Captured with the Phoenix ICON (100° field of view) · wide-field contact fundus photograph of an infant — 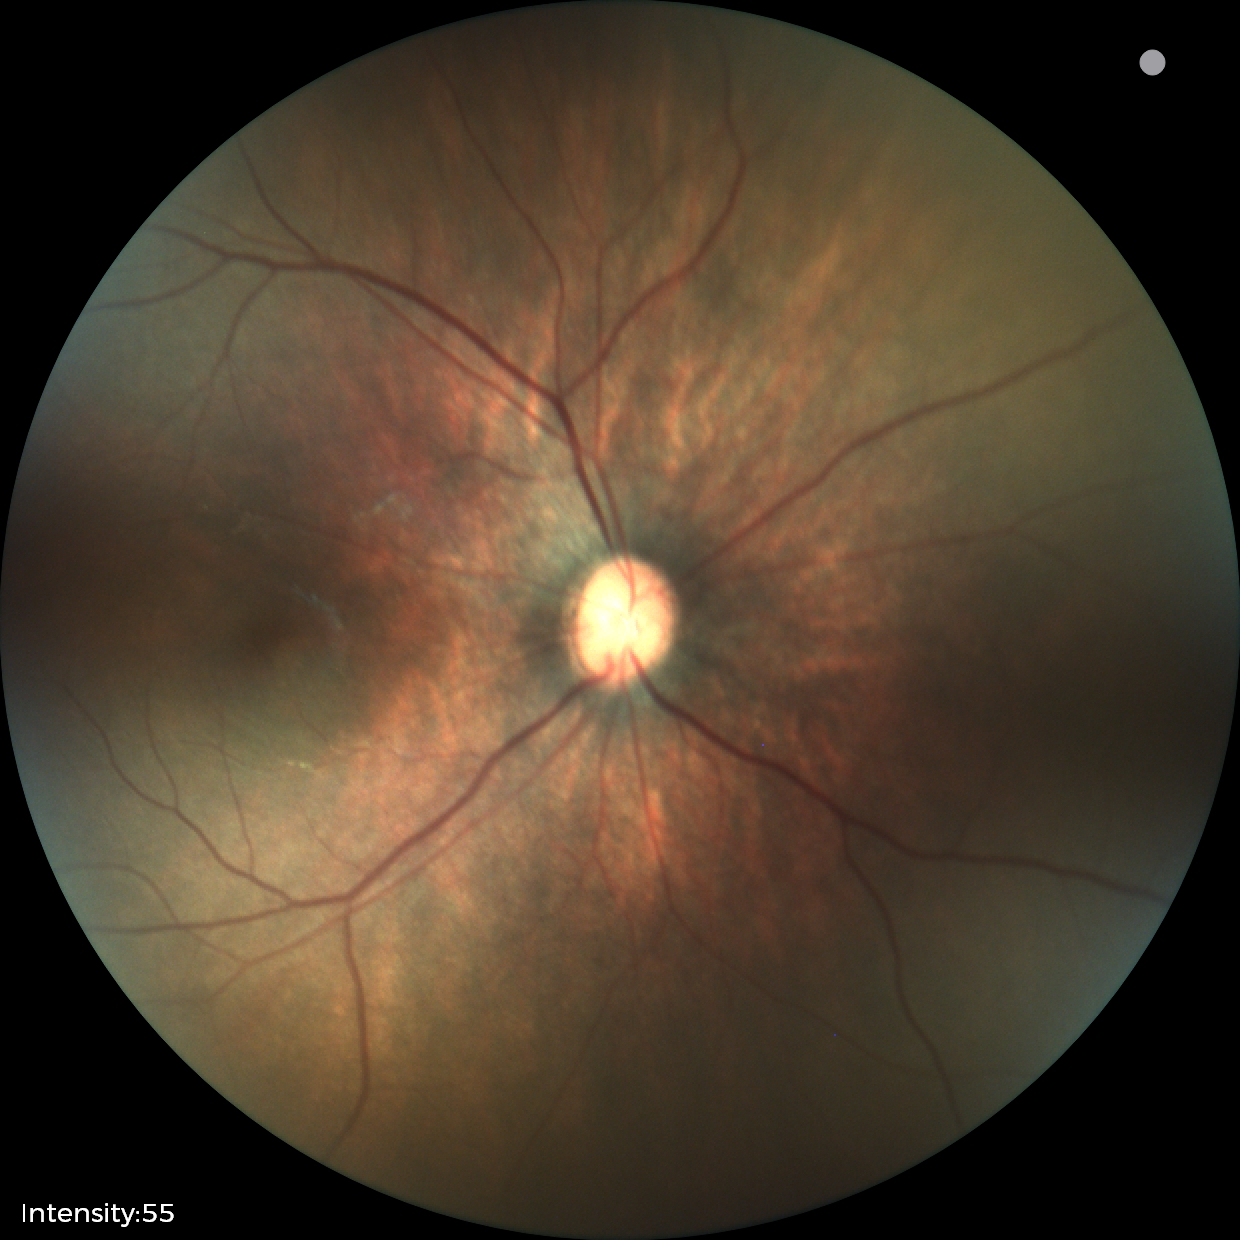
Physiological retinal appearance for postconceptual age.